Acquired with a NIDEK AFC-230:
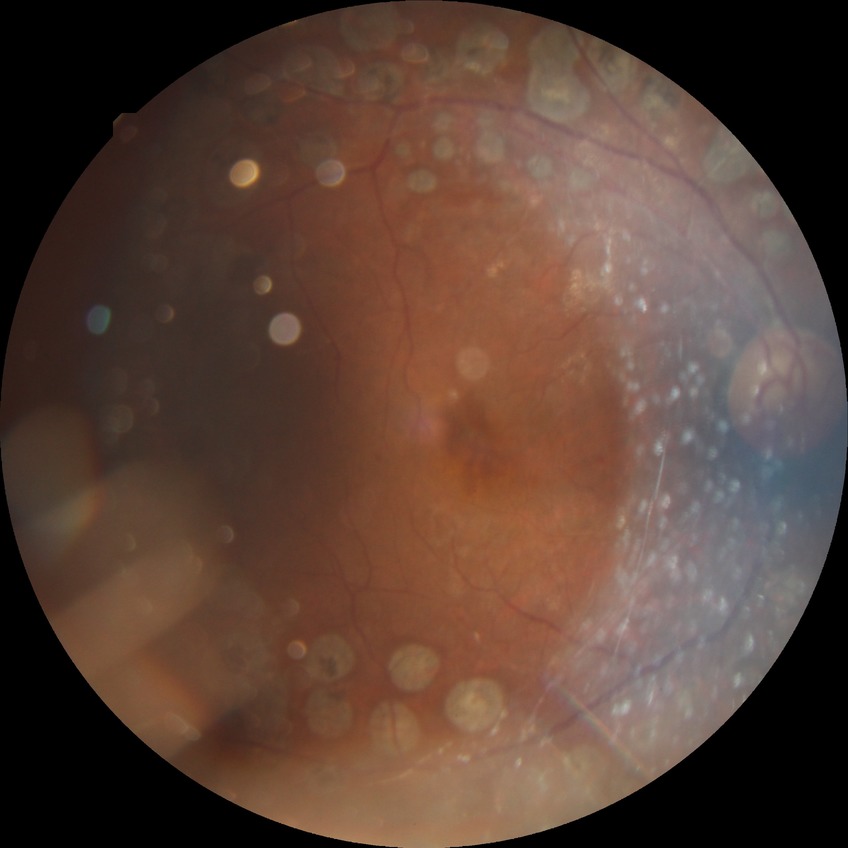
  davis_grade: NDR (no diabetic retinopathy)